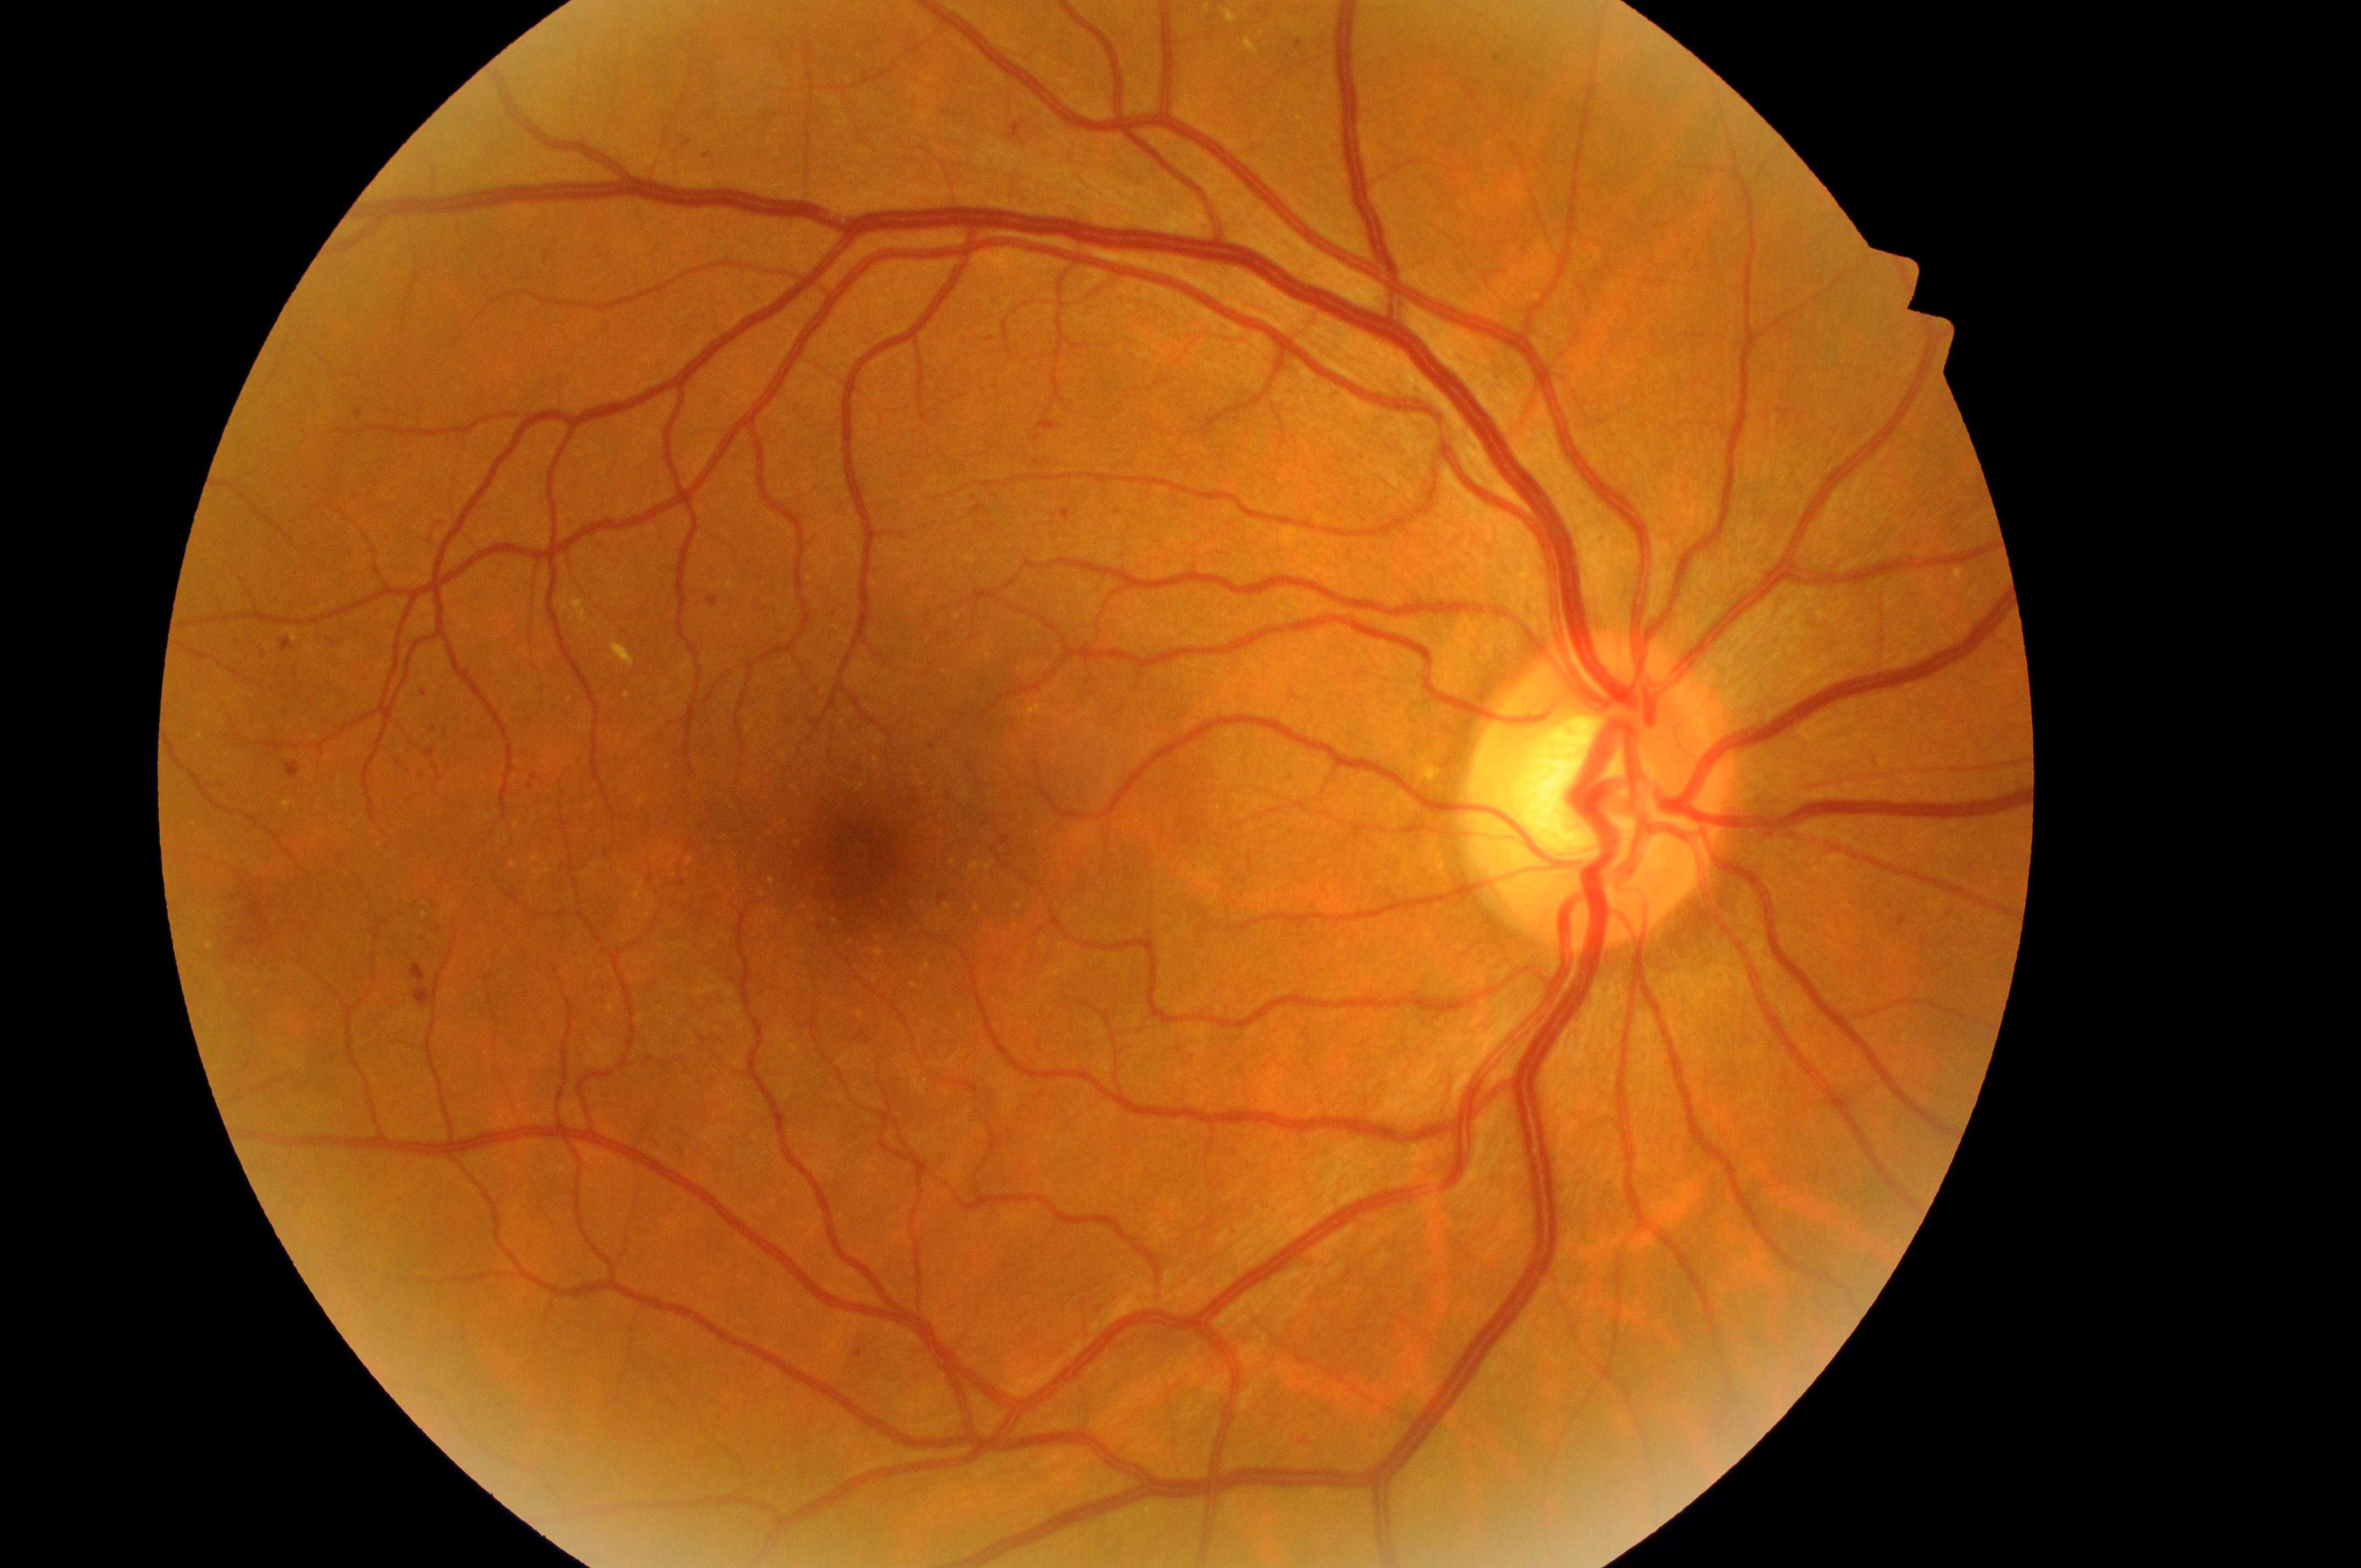

macular edema risk = 1 — hard exudates present, but outside one disc diameter of the macula center | optic disc center = 1595px, 810px | eye = OD | fovea = 864px, 864px | retinopathy grade = 2 — more than just microaneurysms but less than severe NPDR.